Camera: Remidio FOP fundus camera, 1659 x 2212 pixels
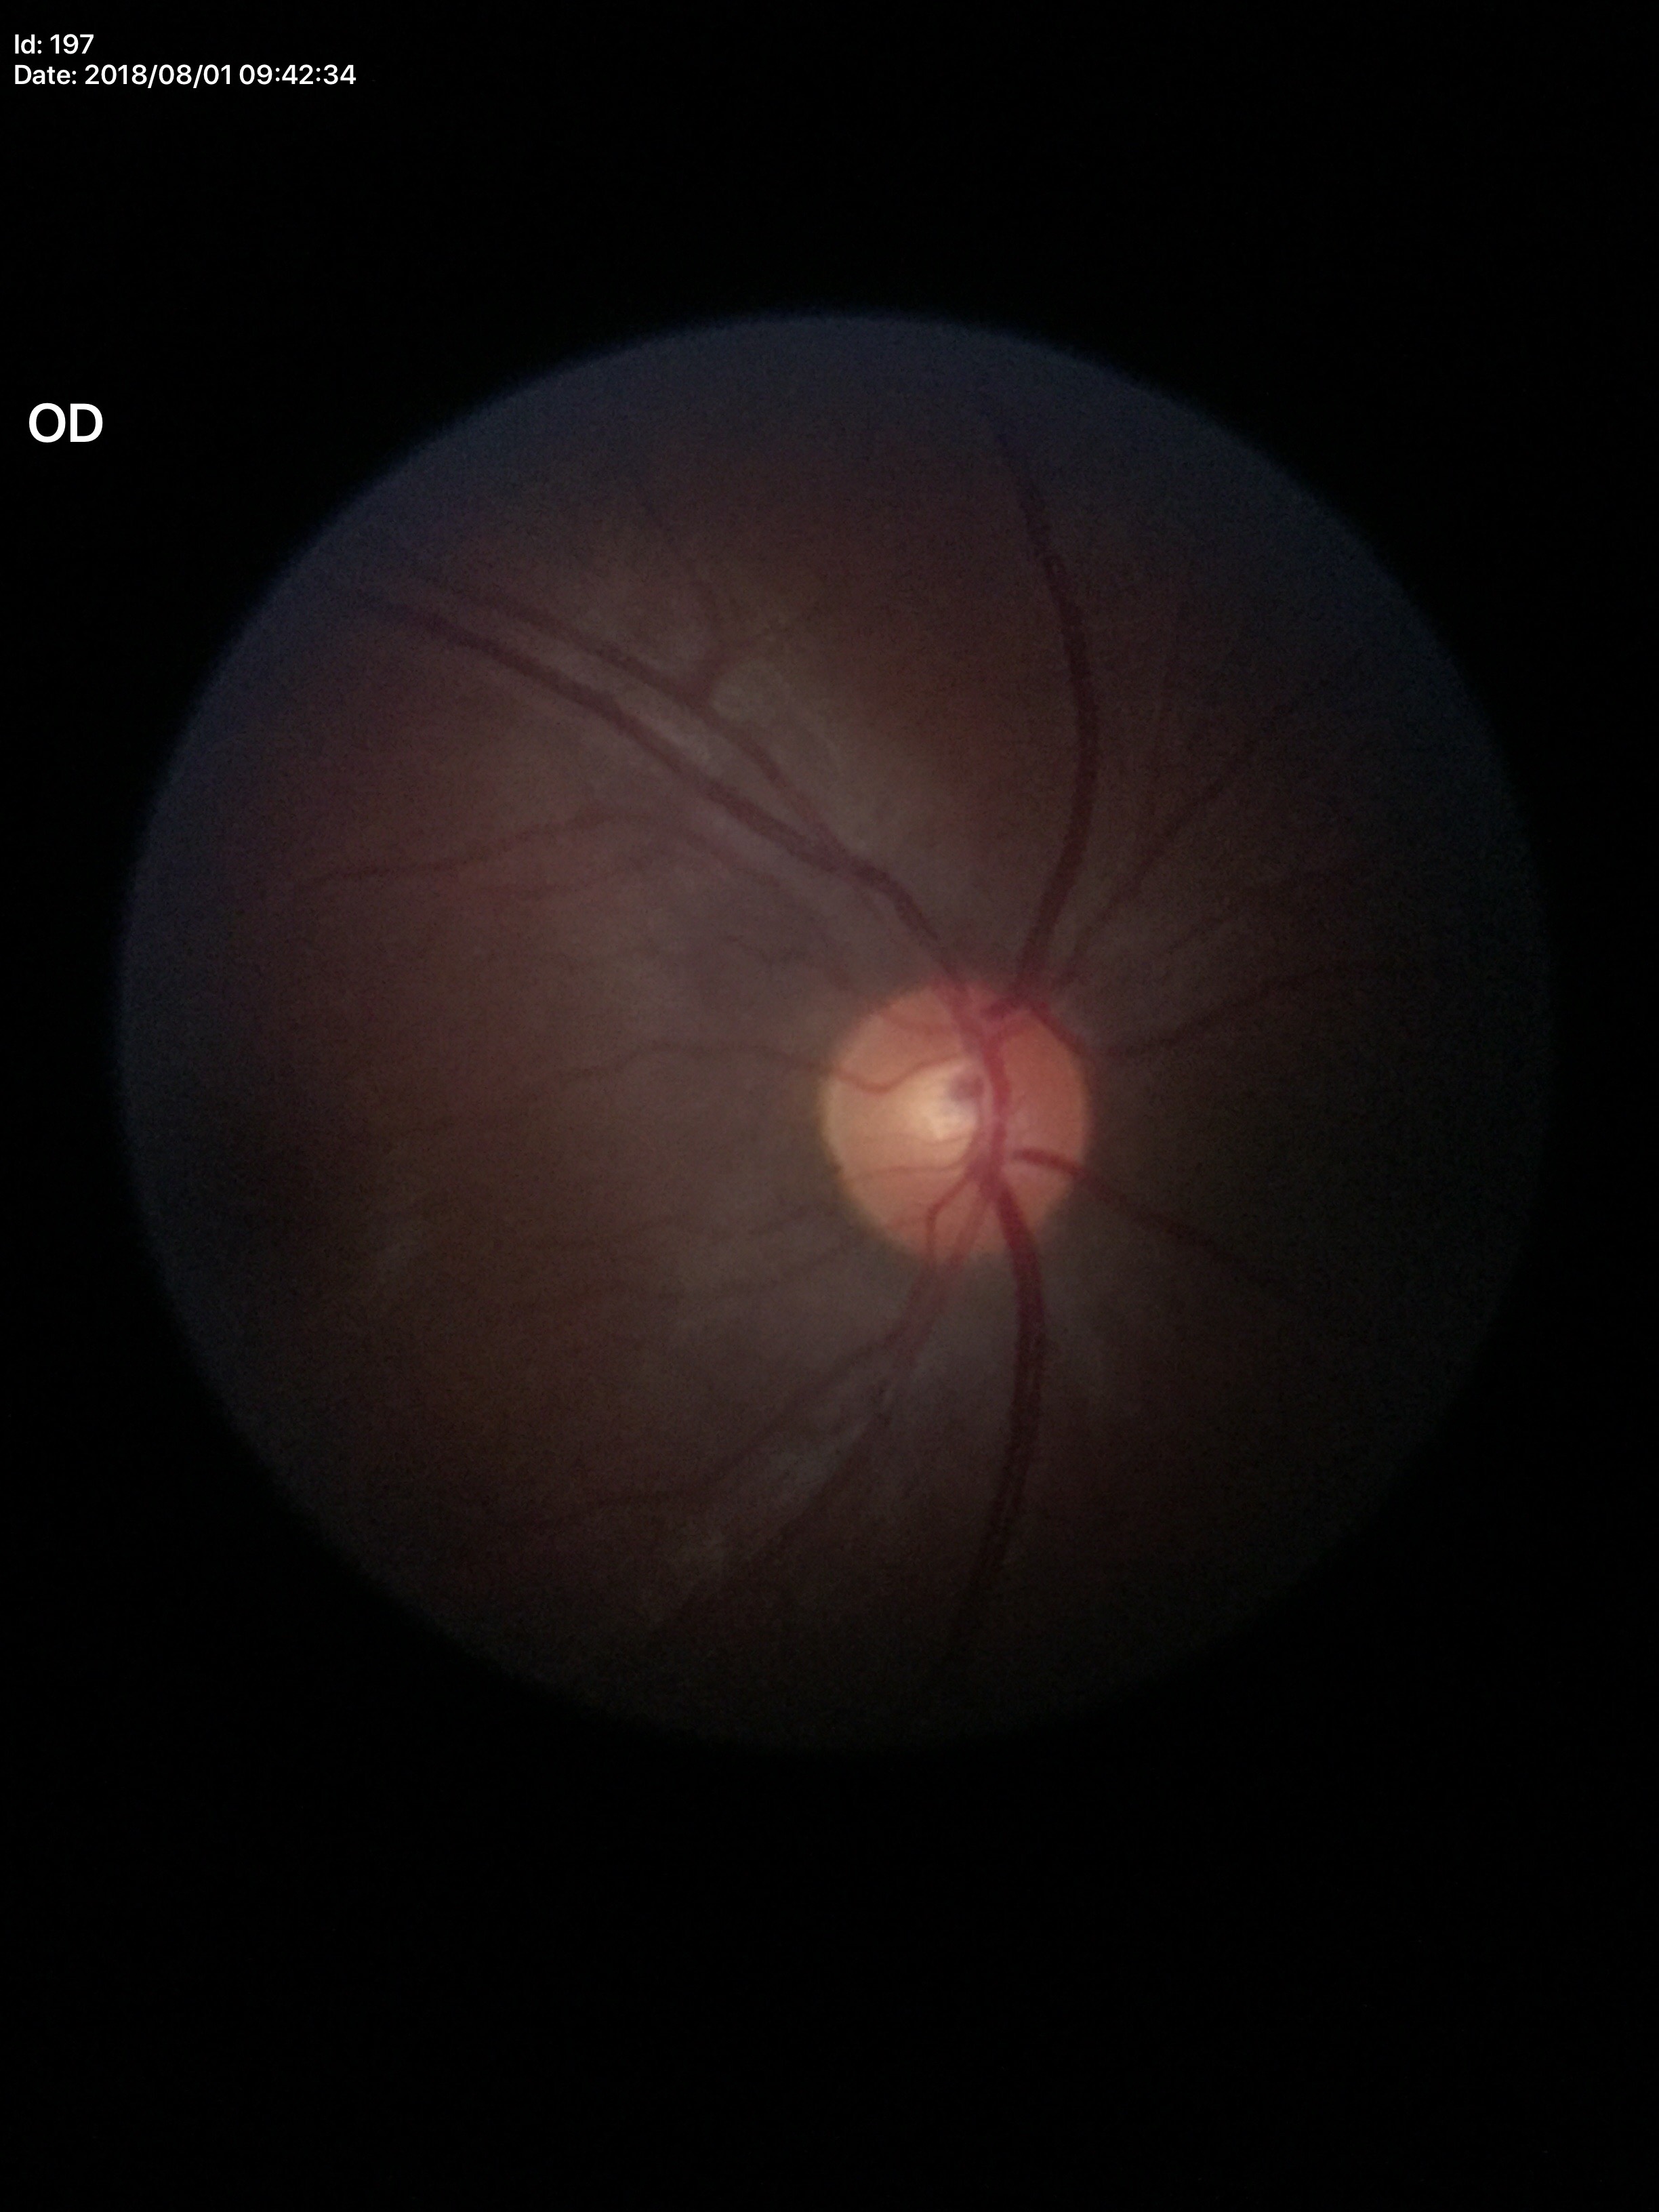 {"hcdr": "0.49", "vcdr": "0.46", "glaucoma_decision": "no suspicious findings (all 5 graders called normal)"}